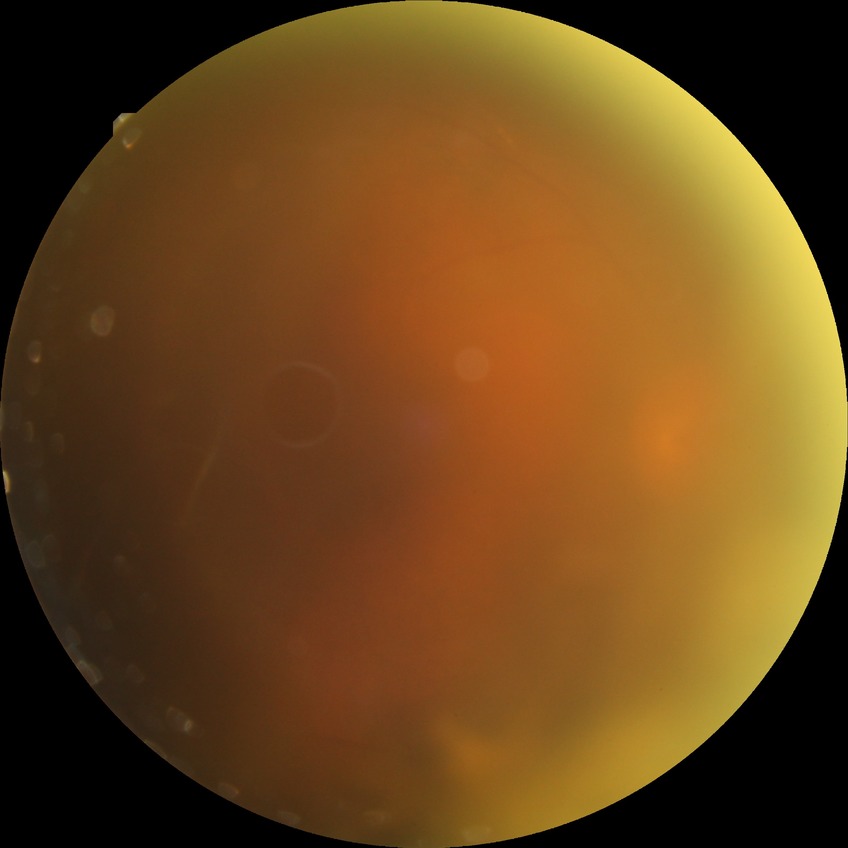 DR grade: PDR.